45-degree field of view: 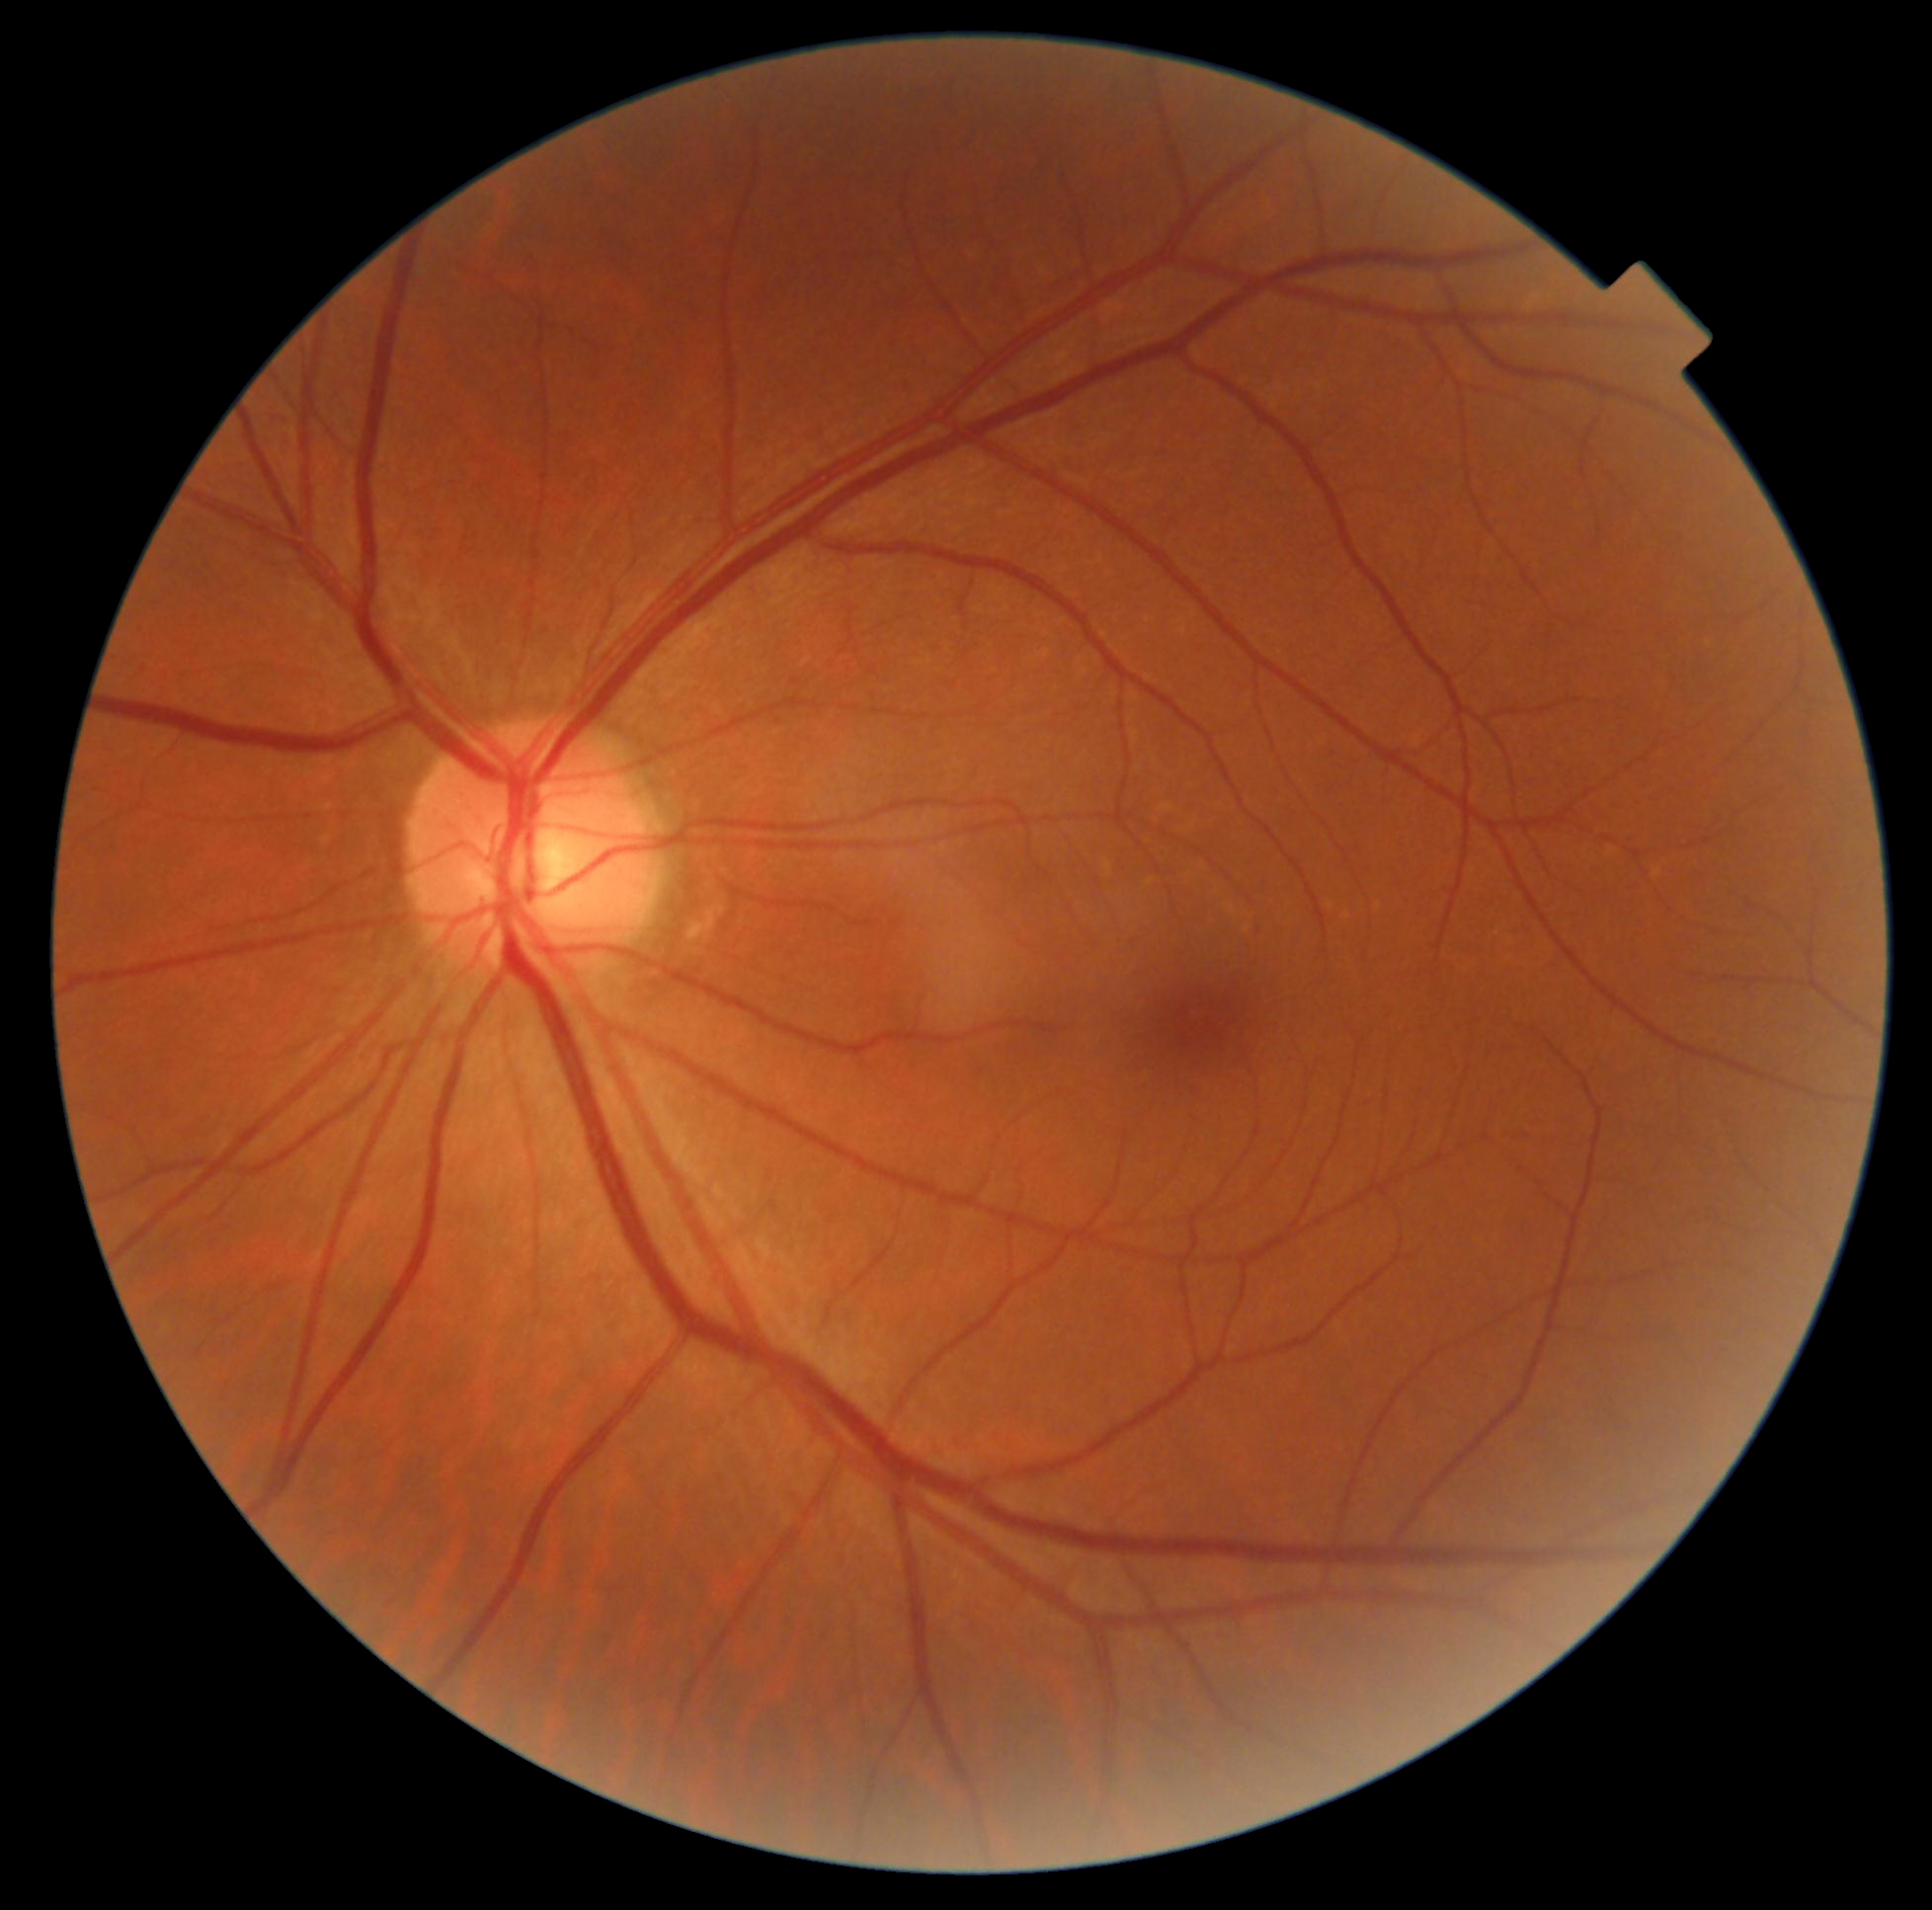 dr_grade: 0/4
dr_impression: negative for DR